Without pupil dilation · modified Davis grading
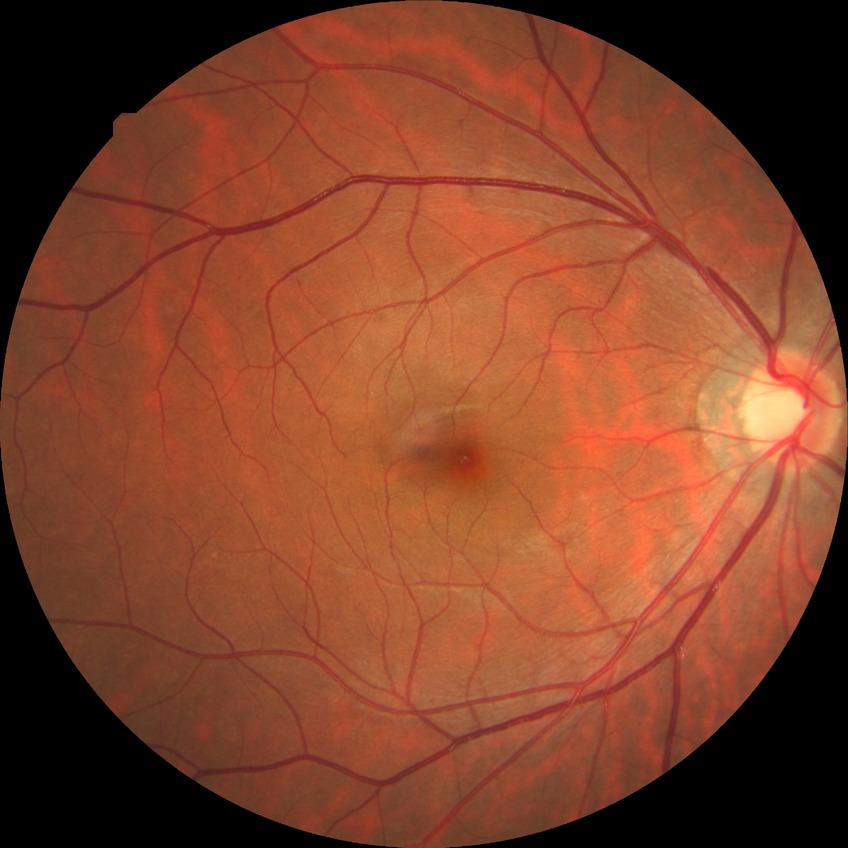

{
  "davis_grade": "no diabetic retinopathy"
}